2352x1568px · 45-degree field of view · fundus photo: 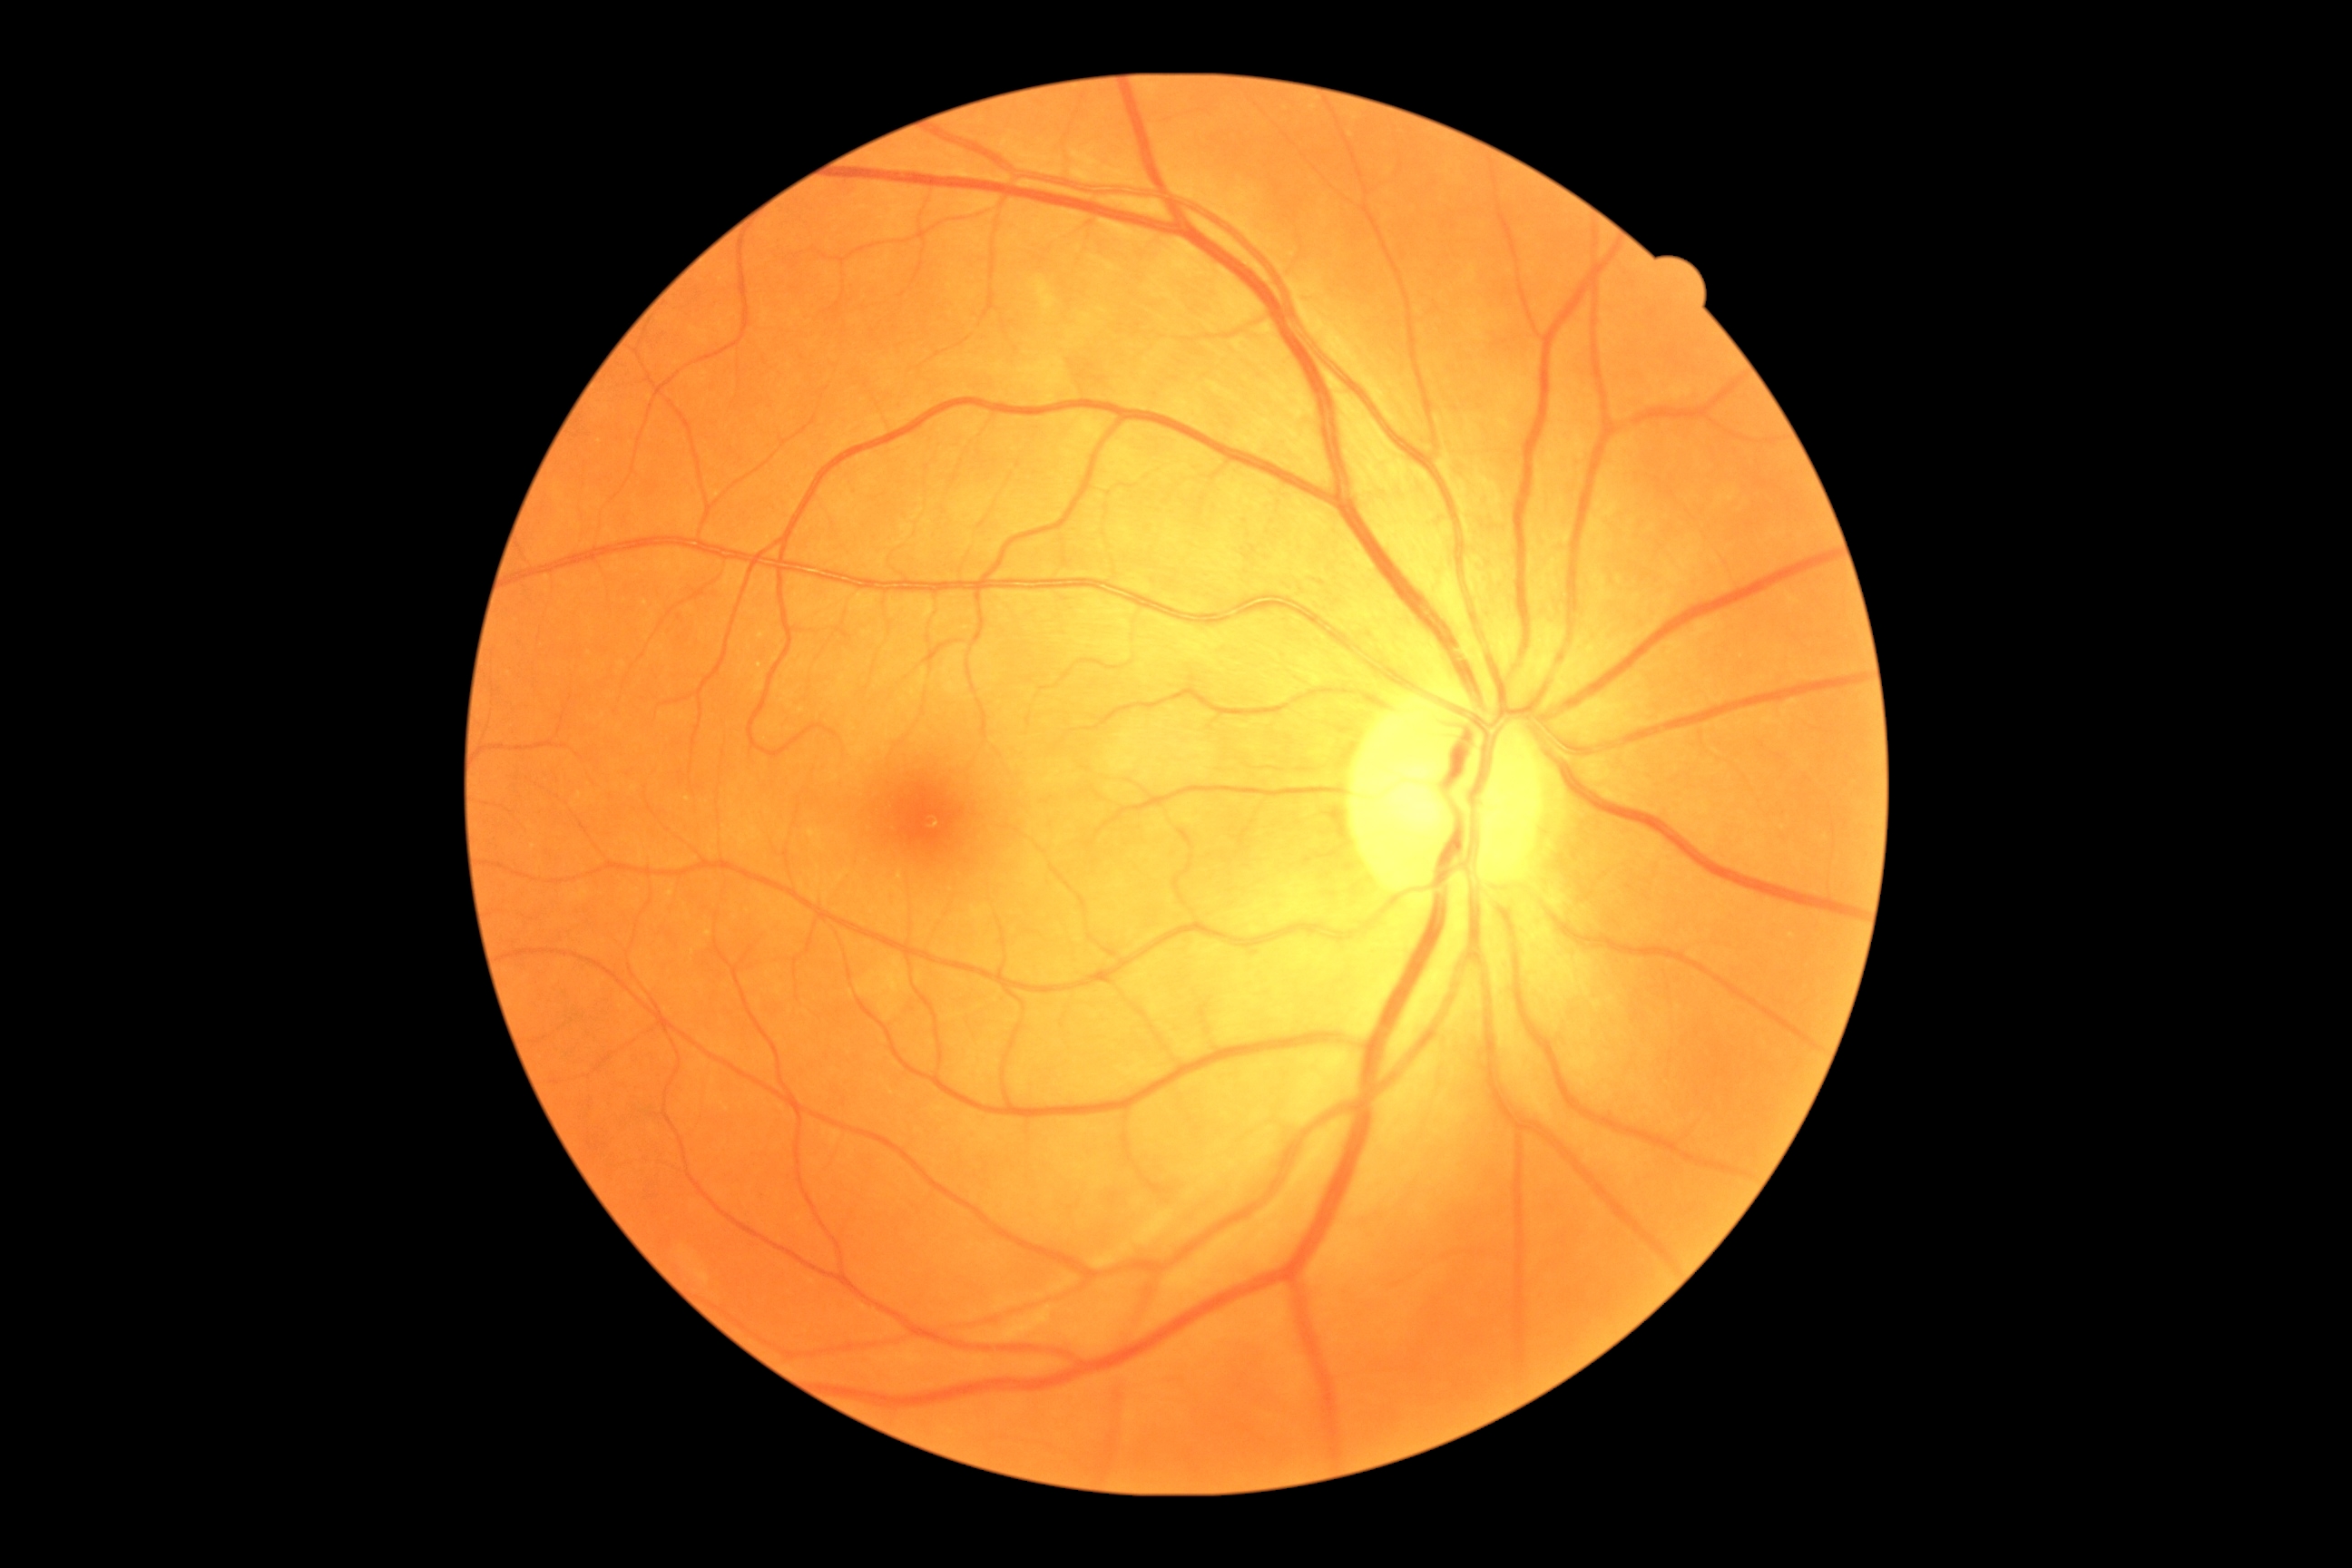
{"dr_grade": "no apparent diabetic retinopathy (0)"}